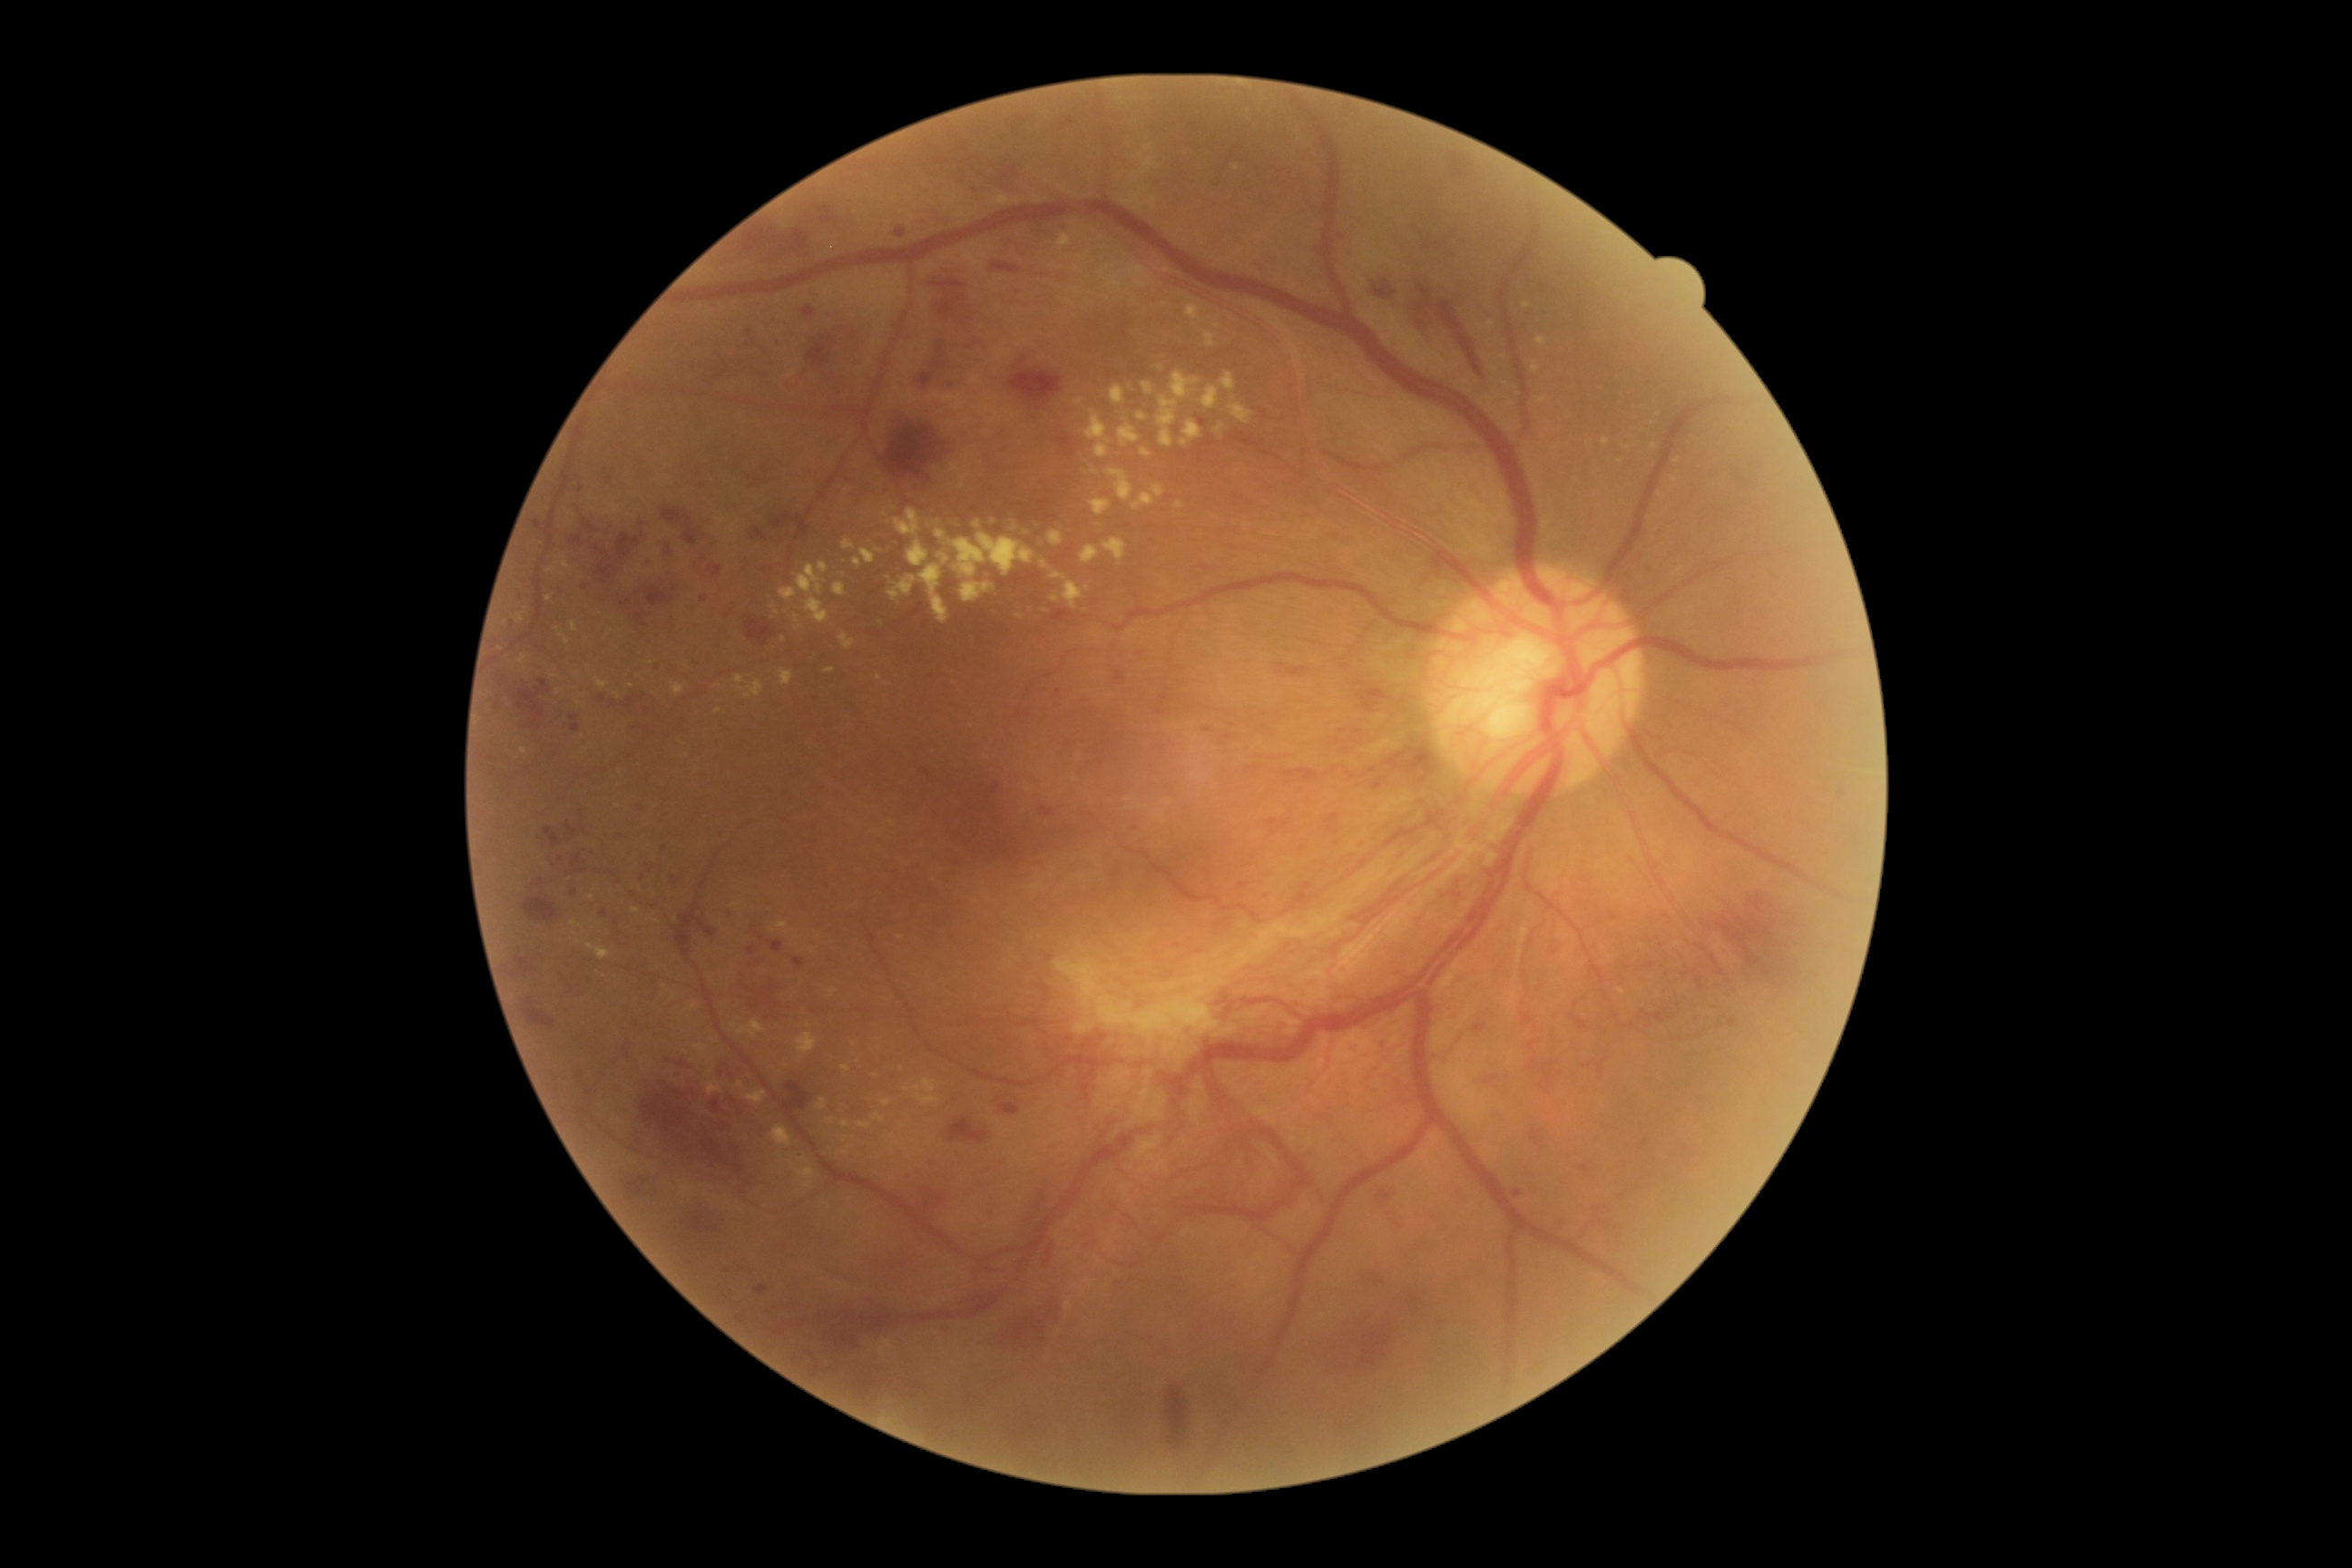

Diabetic retinopathy (DR): grade 4 — neovascularization and/or vitreous/pre-retinal hemorrhage
Selected lesions:
hard exudates (EXs) (partial): 776, 921, 789, 930 | 798, 1168, 816, 1179 | 798, 565, 825, 596 | 1181, 420, 1202, 447 | 1200, 387, 1219, 409 | 874, 1113, 885, 1122 | 818, 562, 828, 574 | 841, 1121, 850, 1128 | 839, 632, 856, 651 | 1137, 413, 1146, 422
Small EXs near pt(1055, 599) | pt(1628, 449) | pt(808, 1186) | pt(740, 1085) | pt(558, 693) | pt(1543, 401) | pt(554, 677) | pt(1246, 527)